2048x1536 · 45-degree field of view.
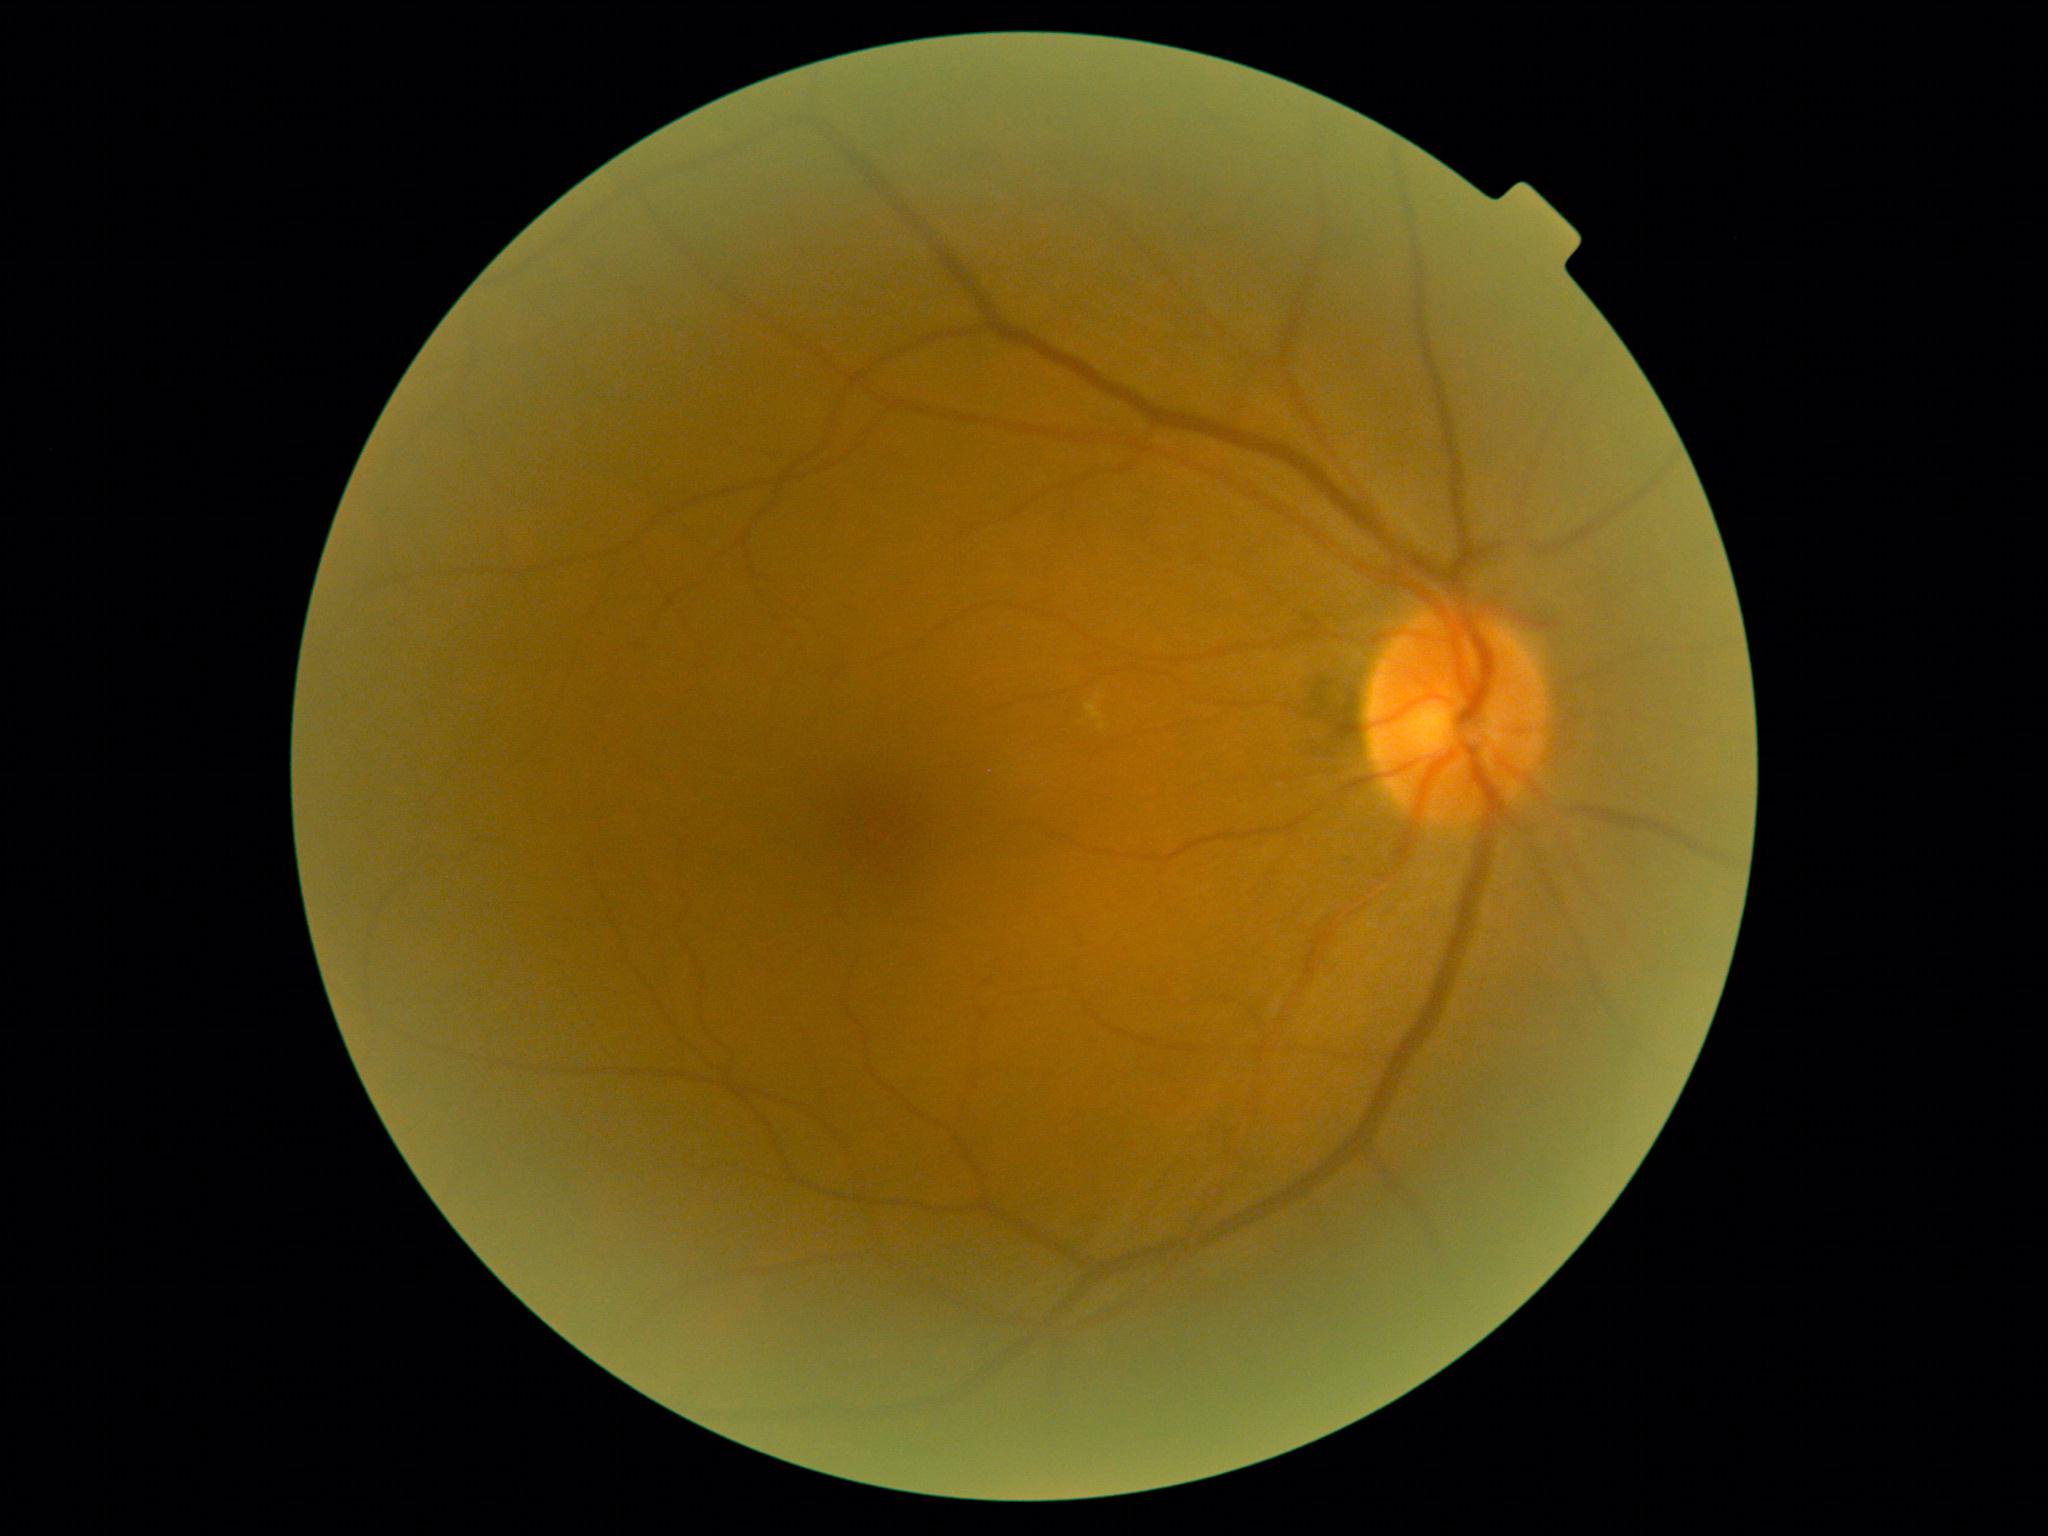 {
  "dr_grade": "moderate non-proliferative diabetic retinopathy (grade 2)"
}